848x848px, NIDEK AFC-230 fundus camera: 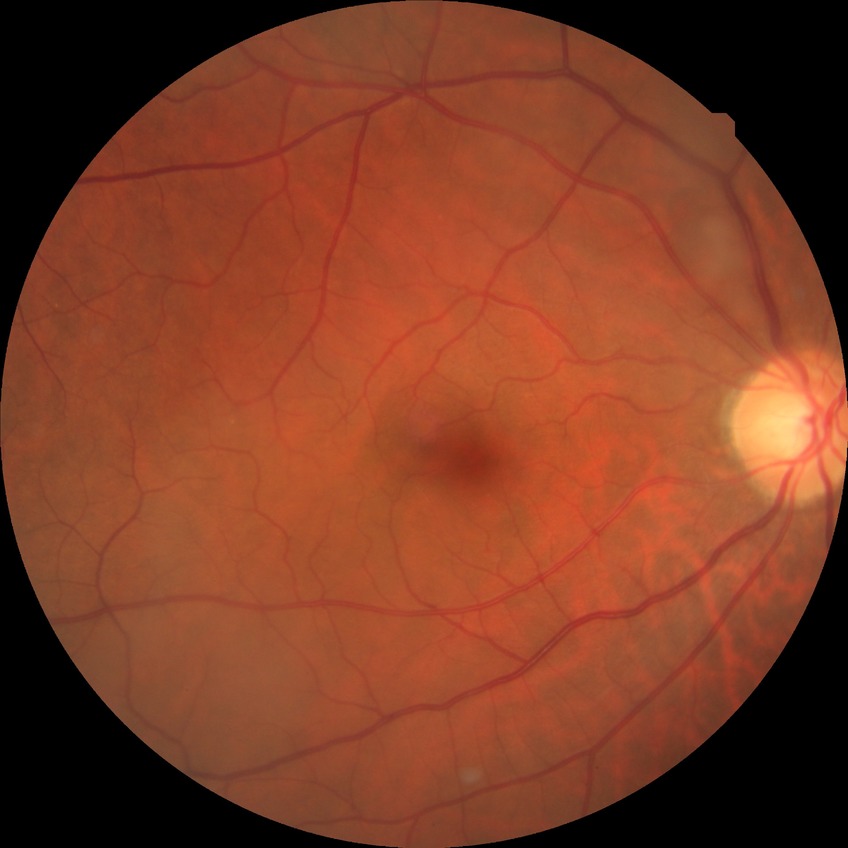
davis_grade: NDR